Modified Davis grading · nonmydriatic: 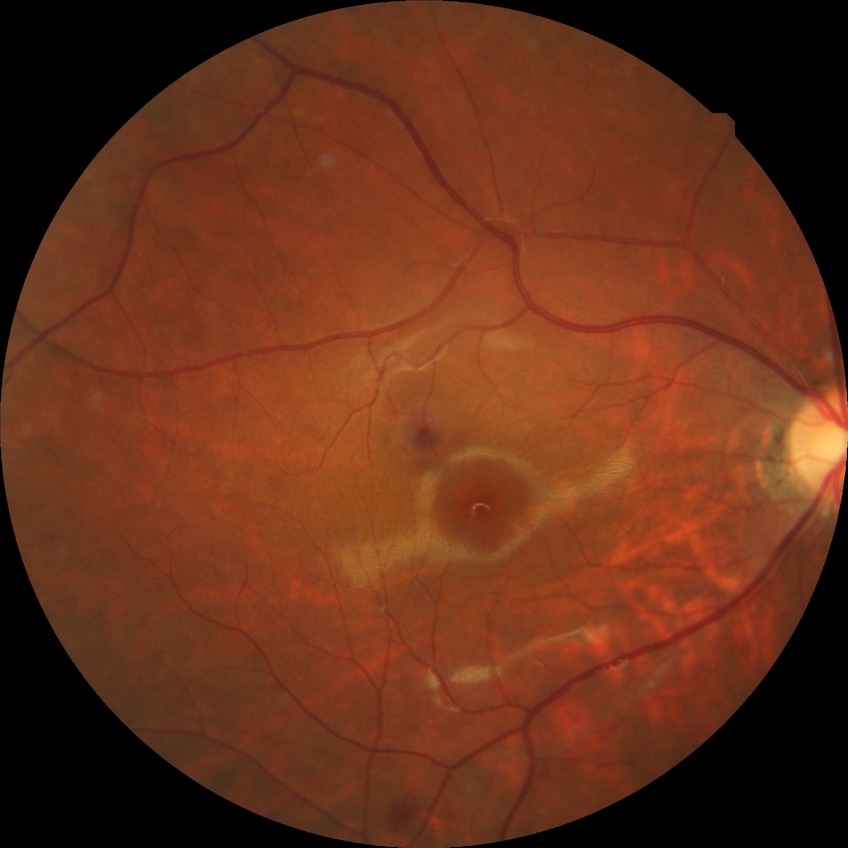 Diabetic retinopathy (DR): simple diabetic retinopathy (SDR).